FOV: 45 degrees, 2352 x 1568 pixels, color fundus image
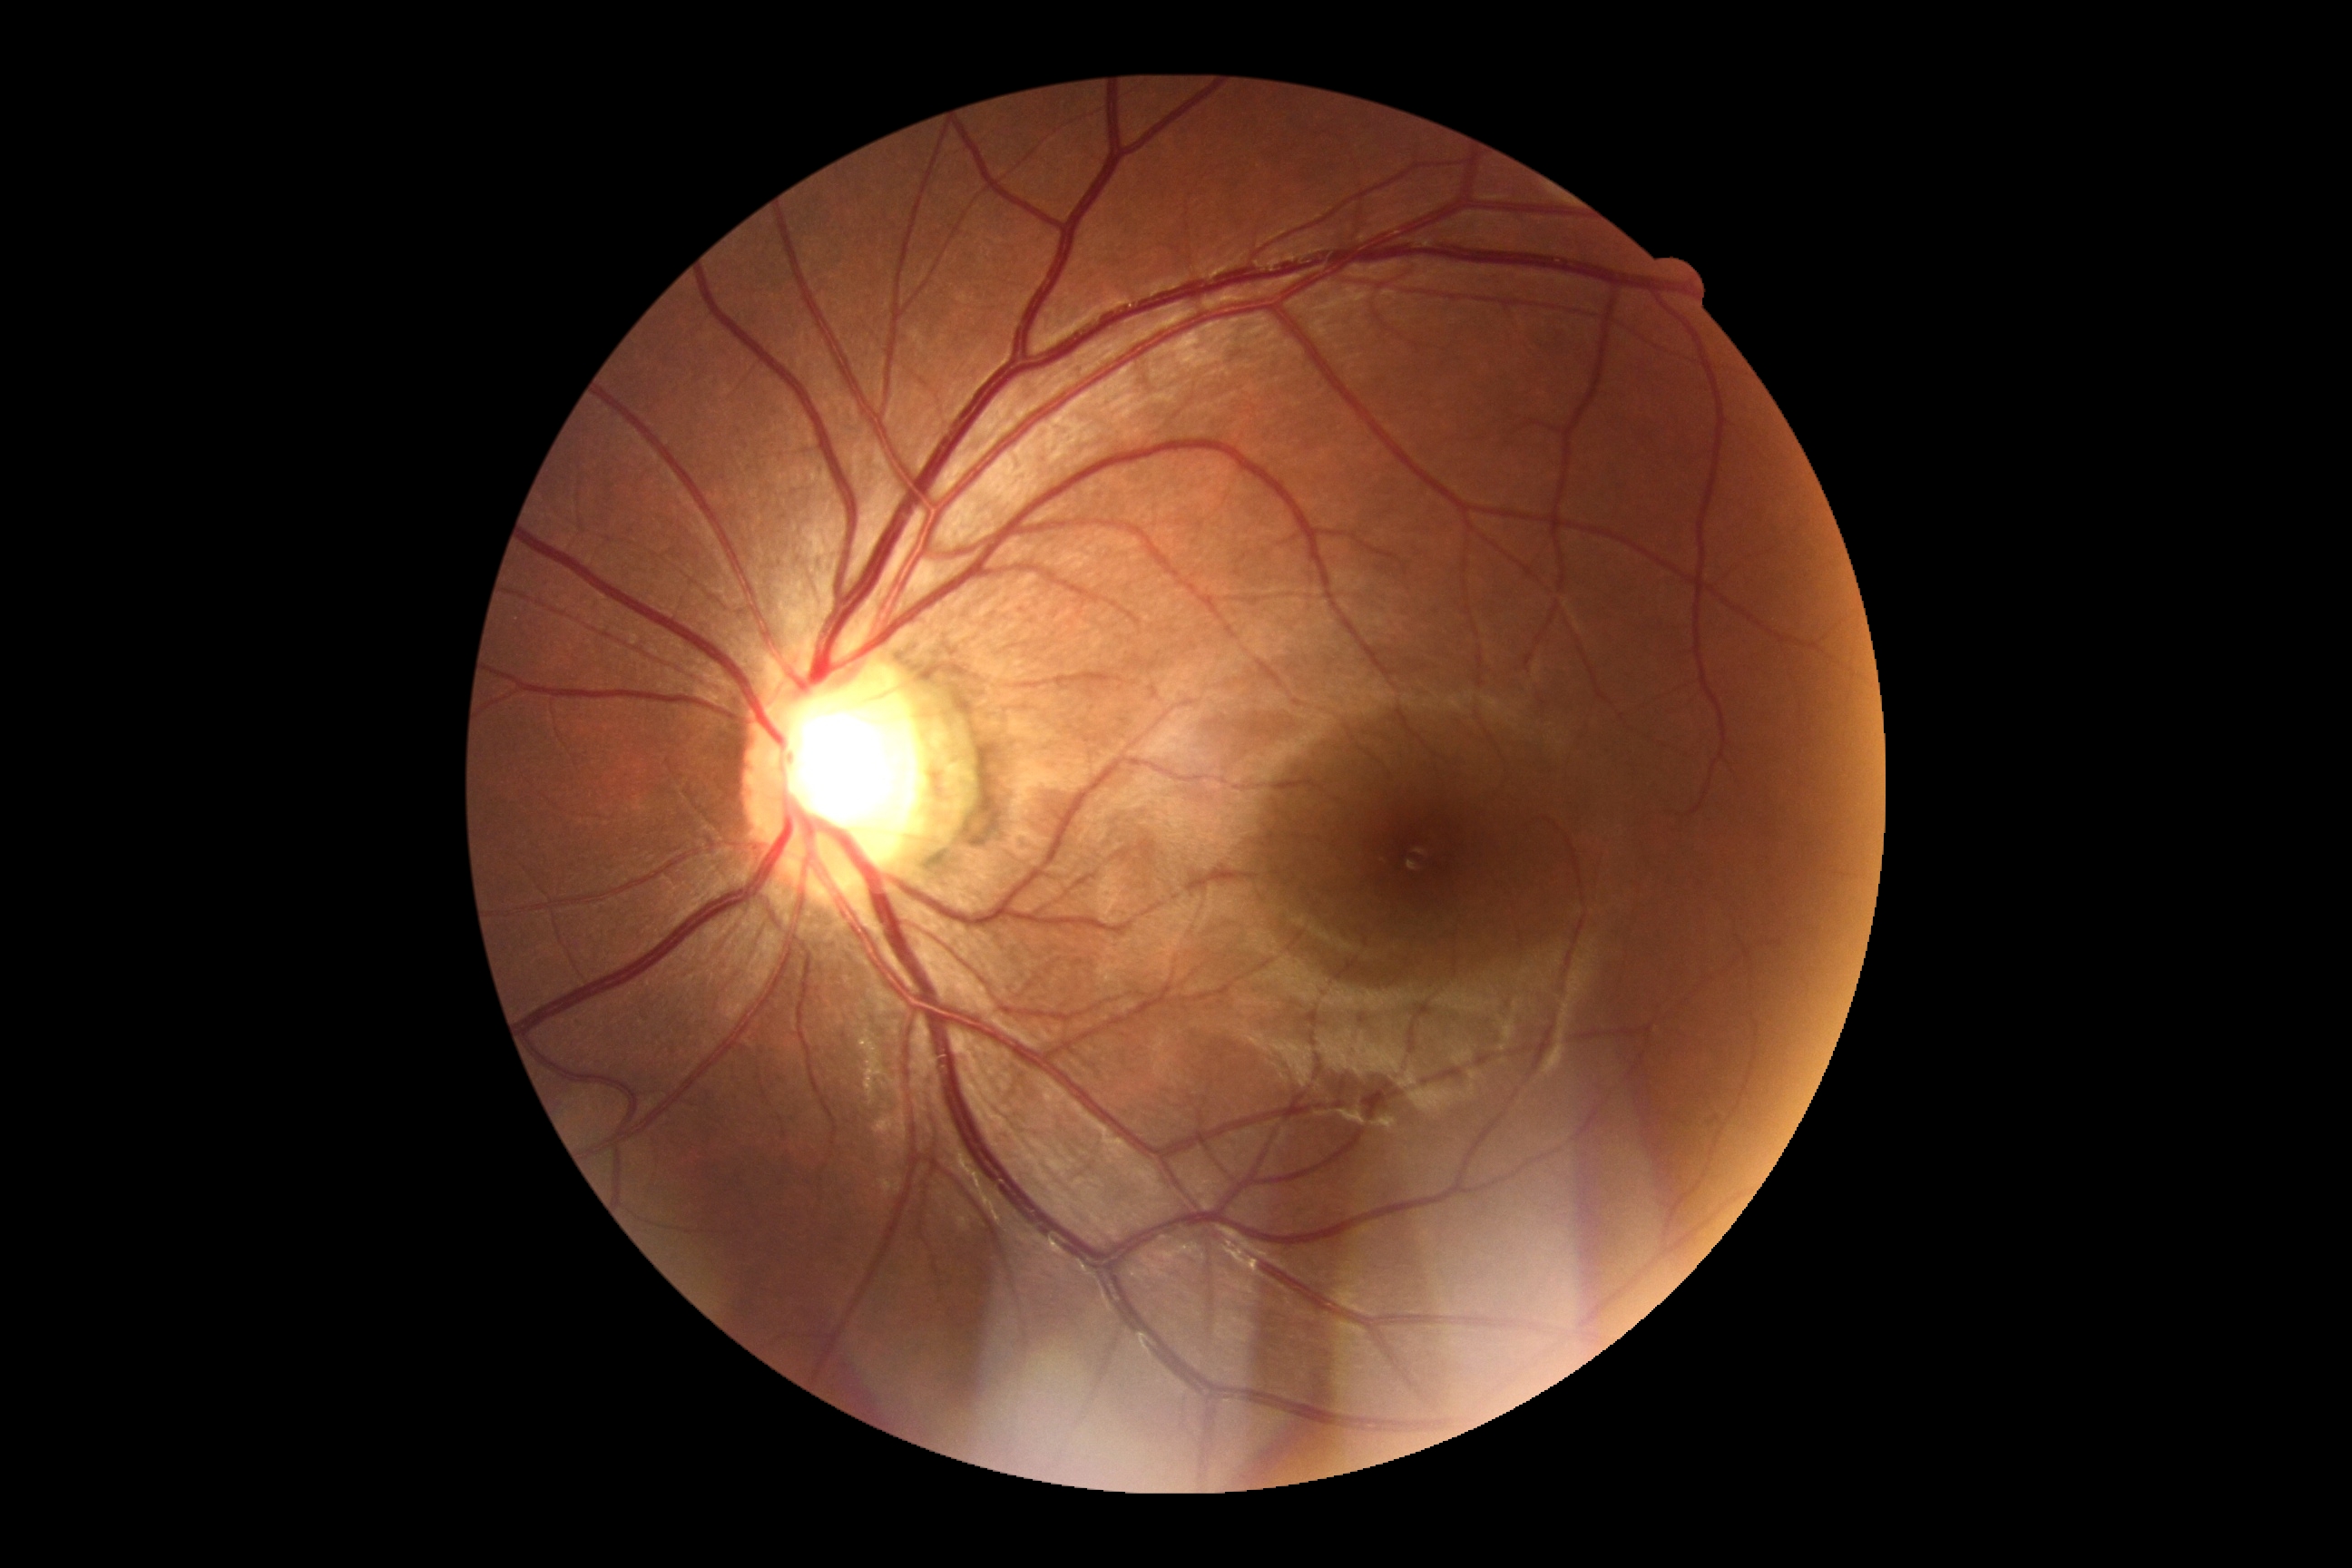
Retinopathy is grade 0. No signs of diabetic retinopathy.